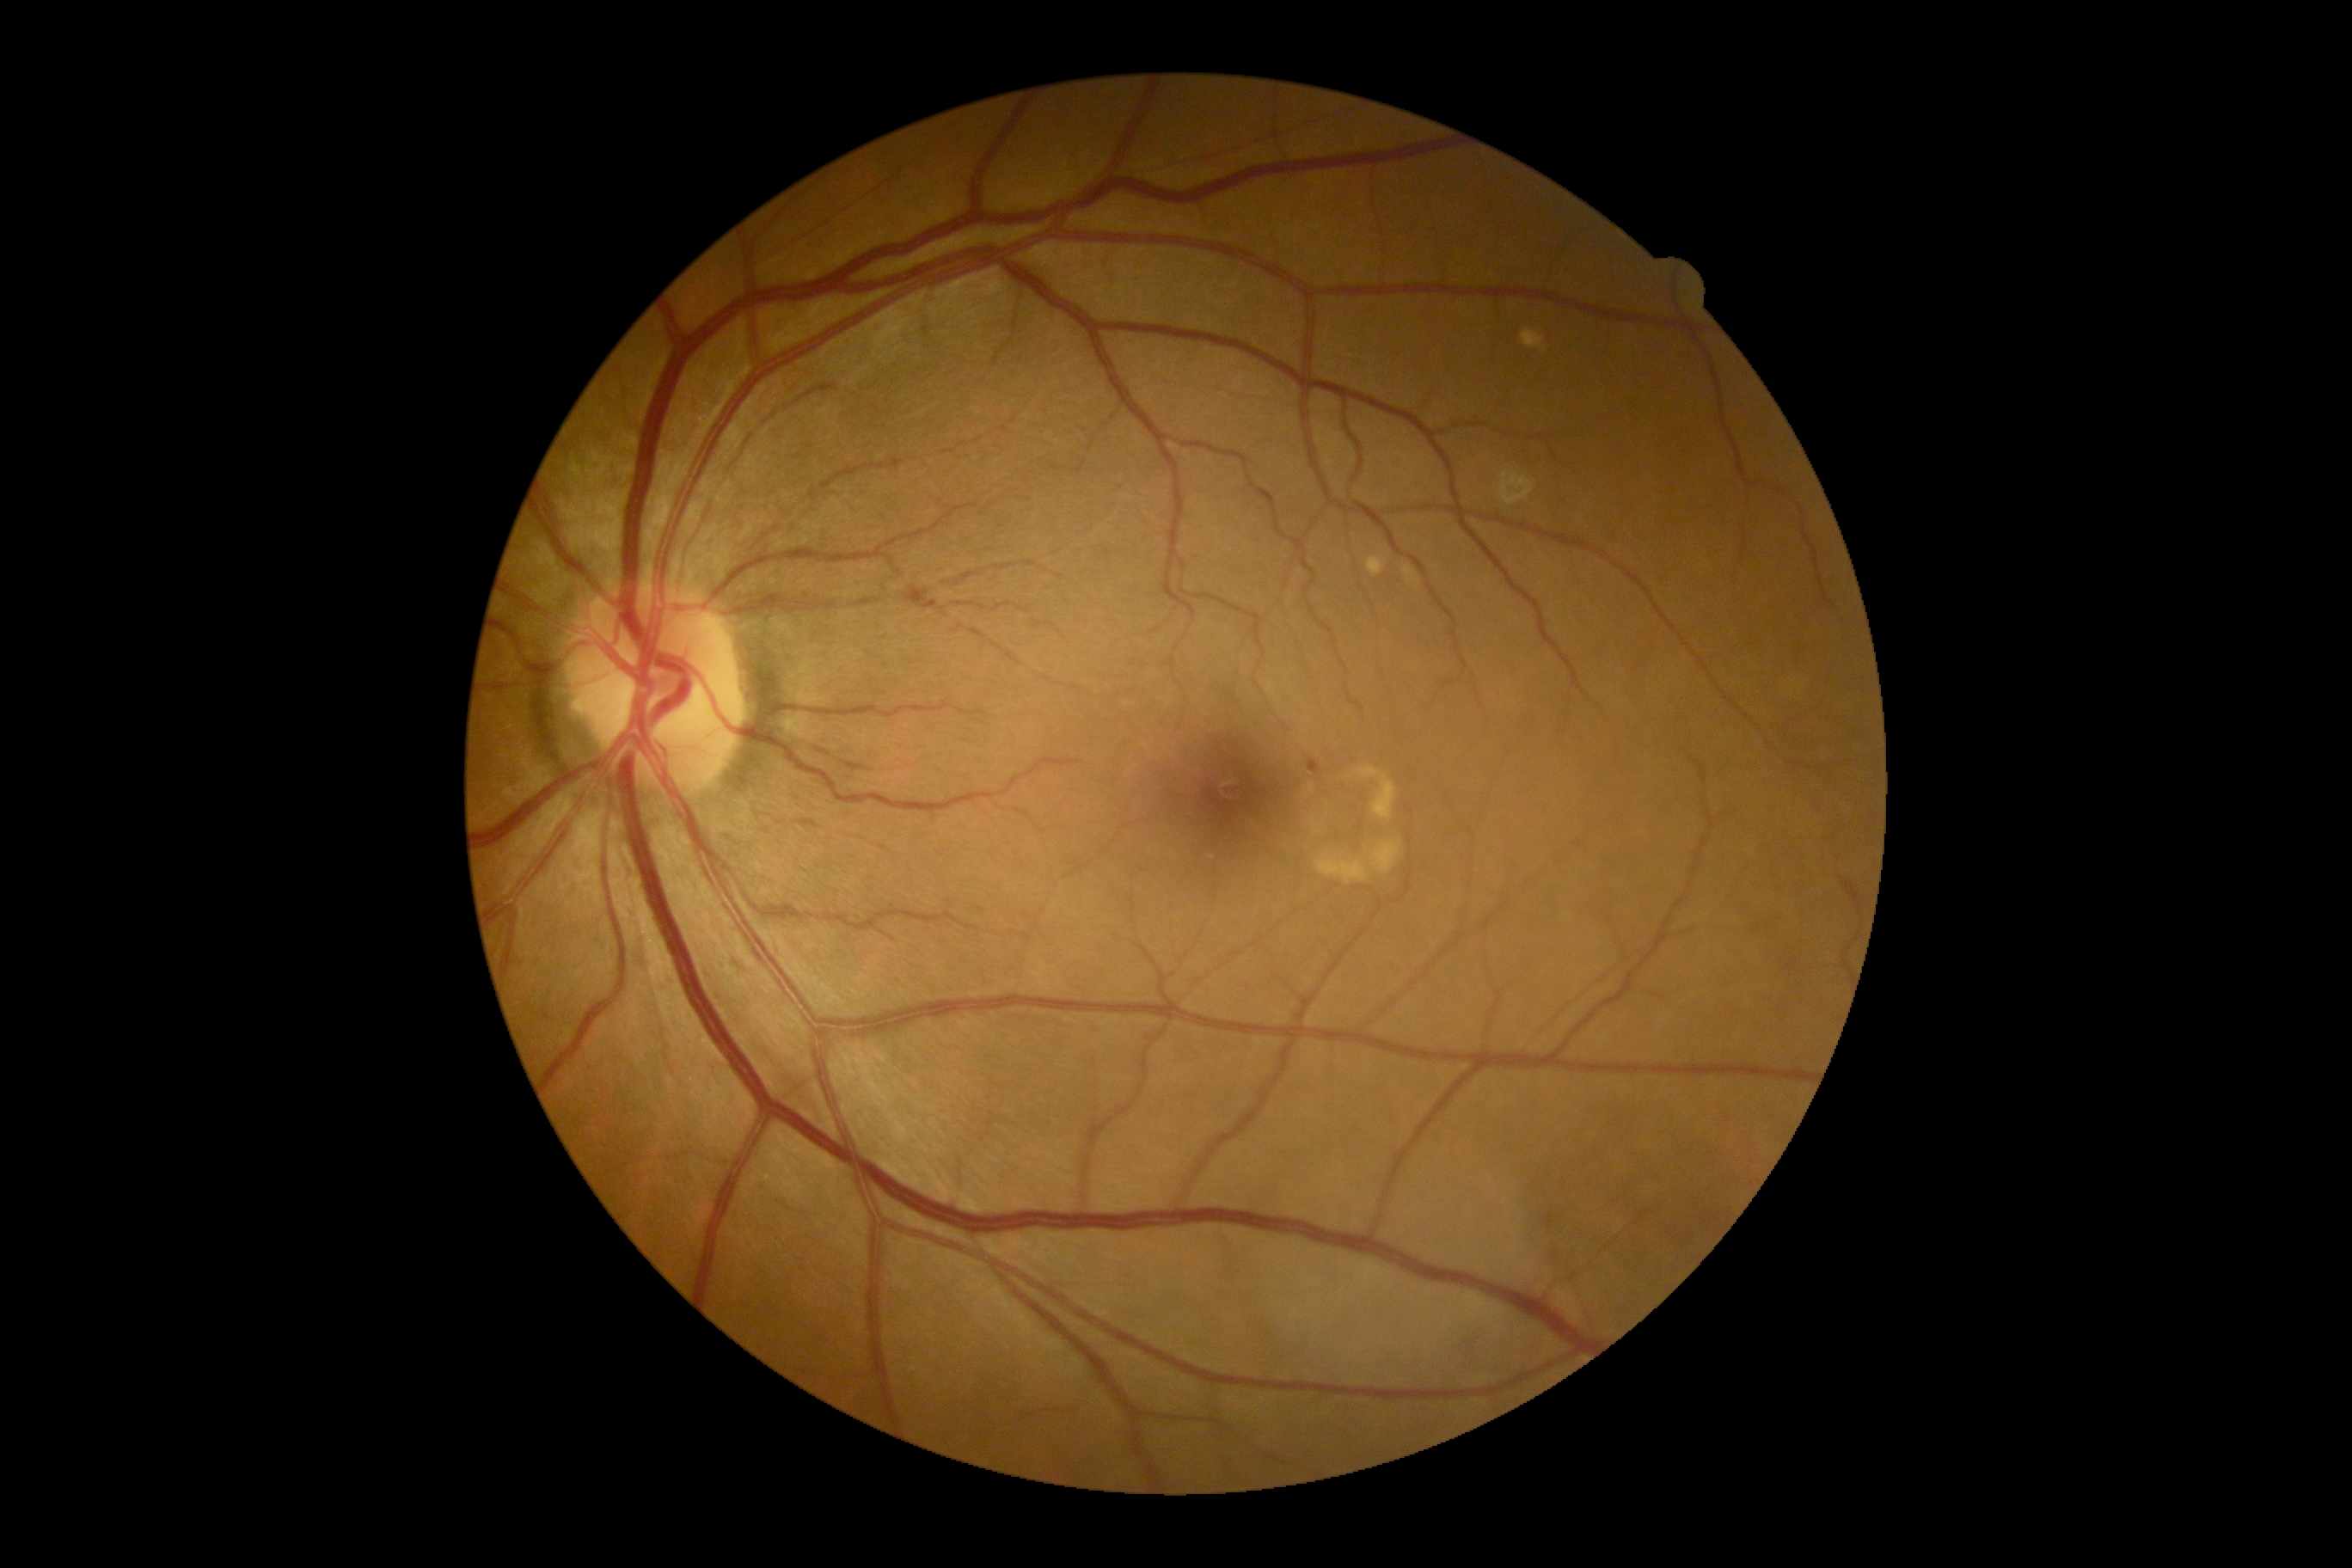

Diabetic retinopathy (DR): 1.